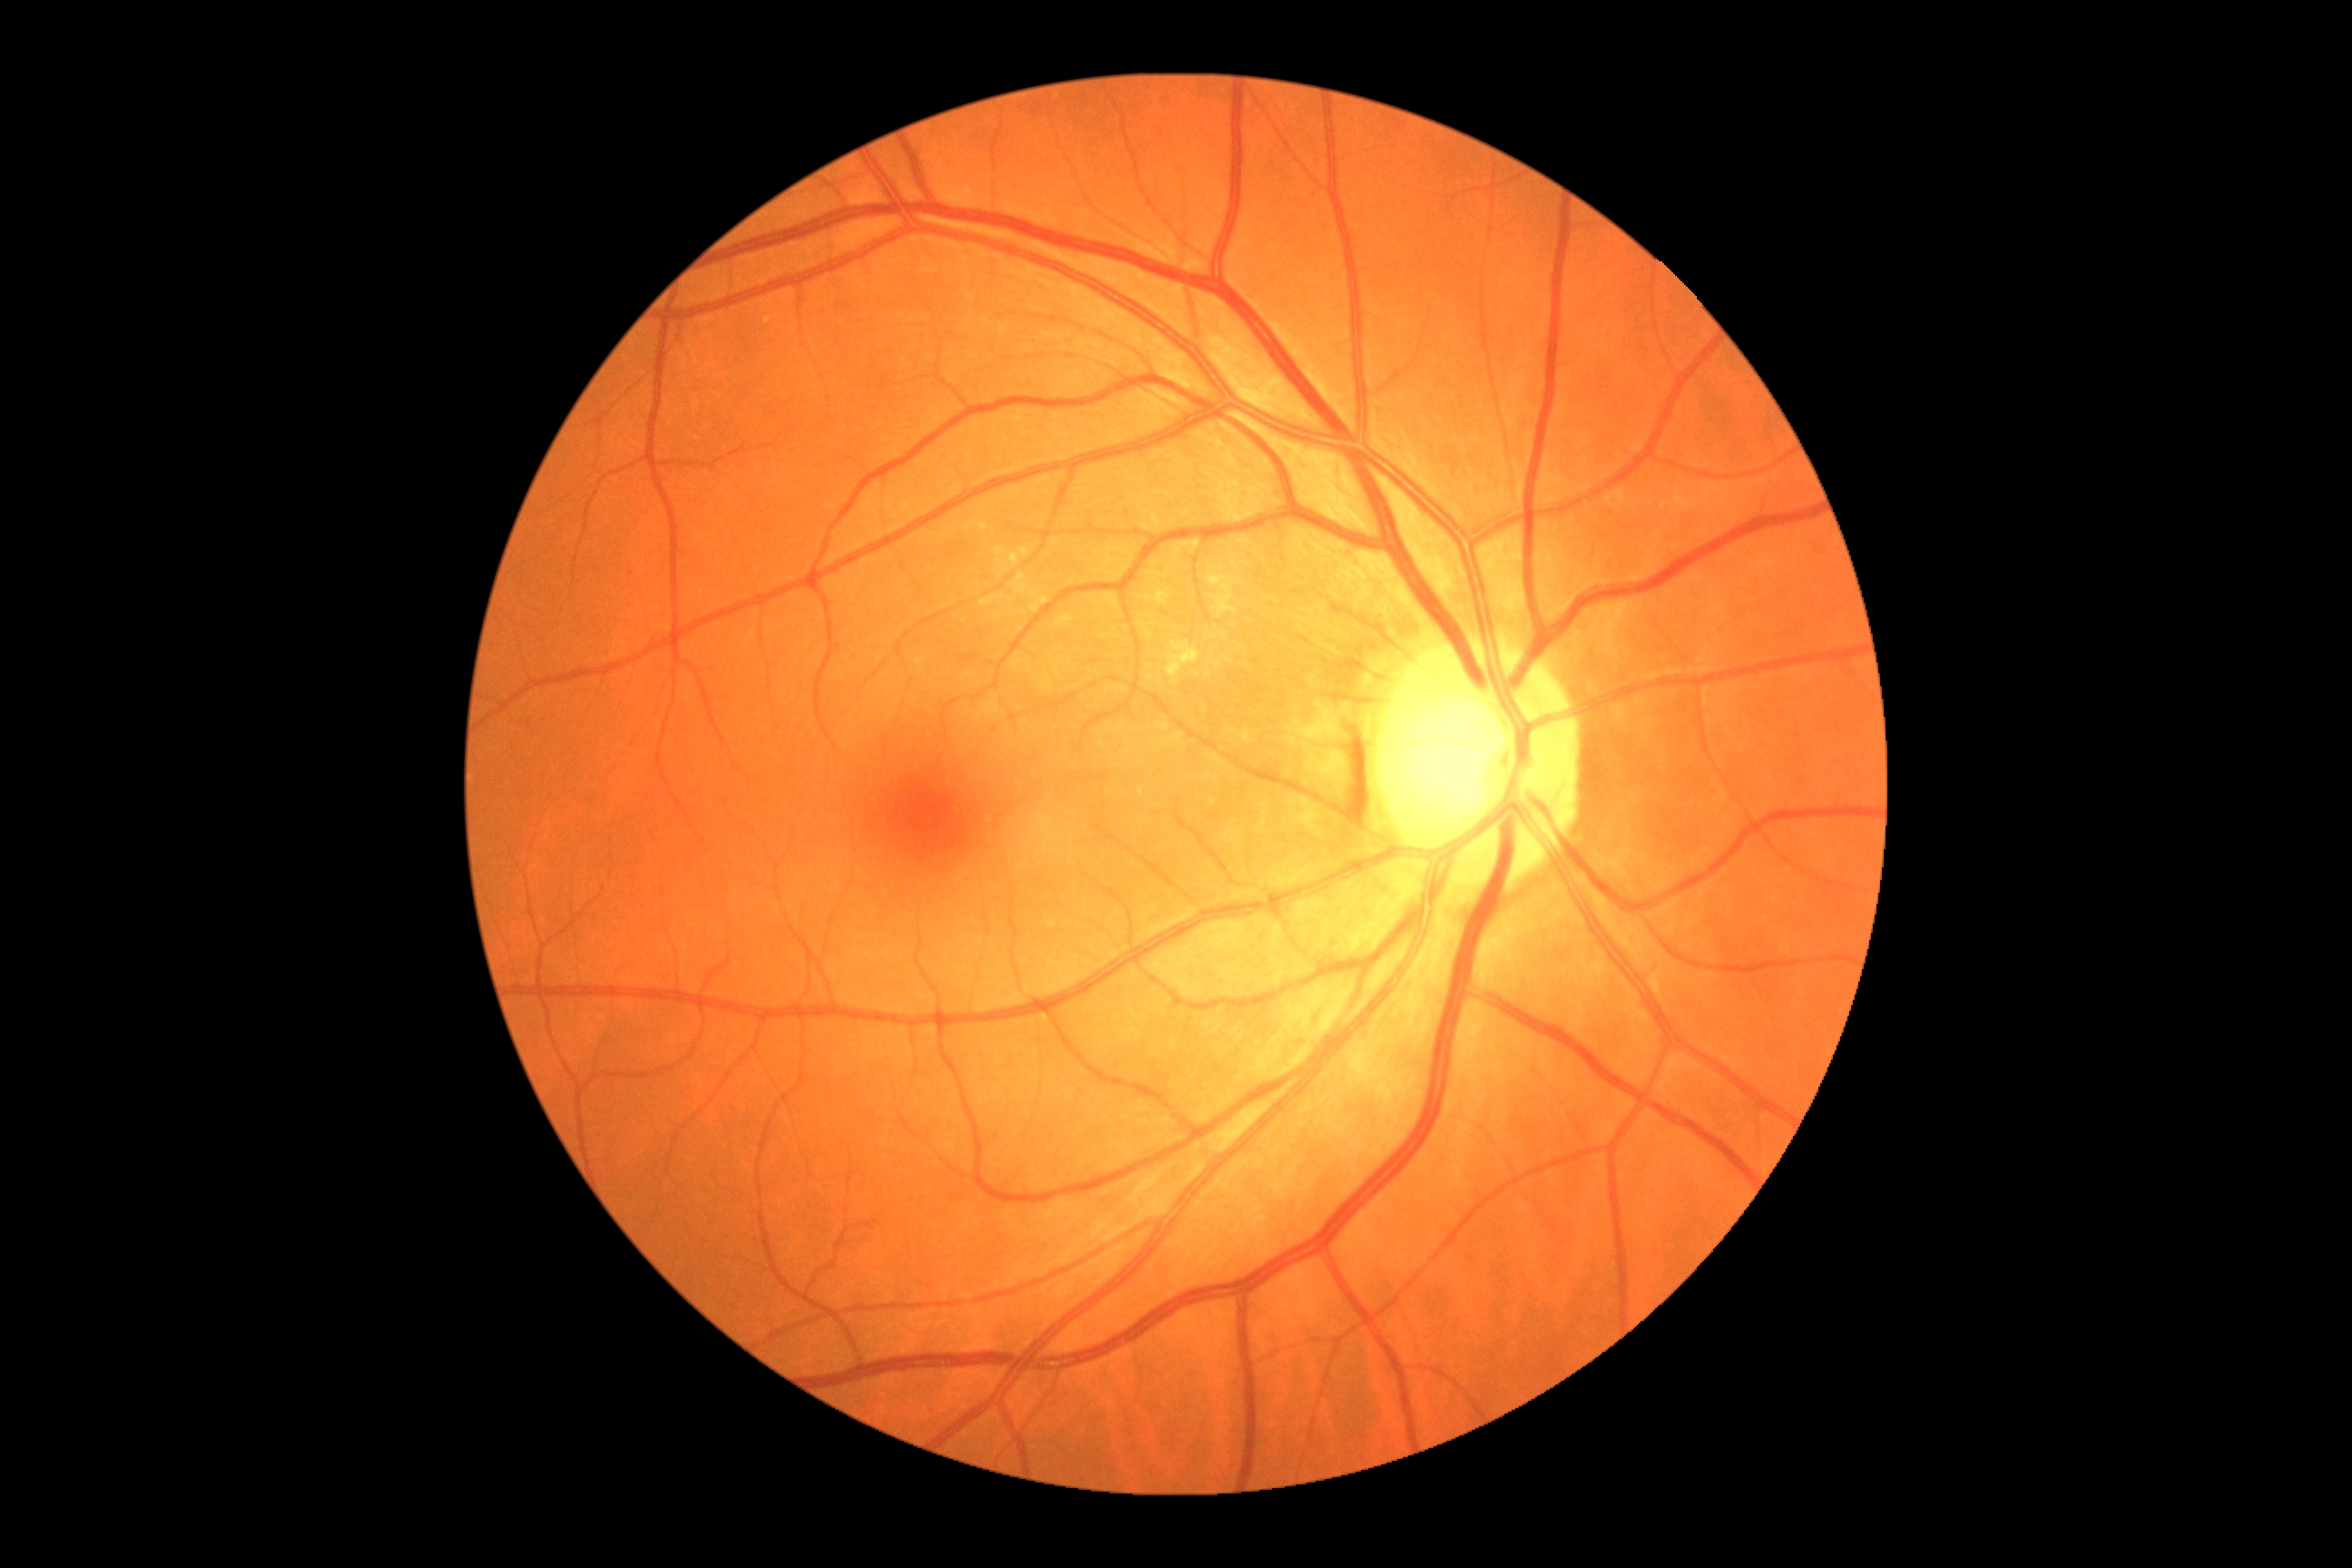
DR: grade 0.